Retinal fundus photograph
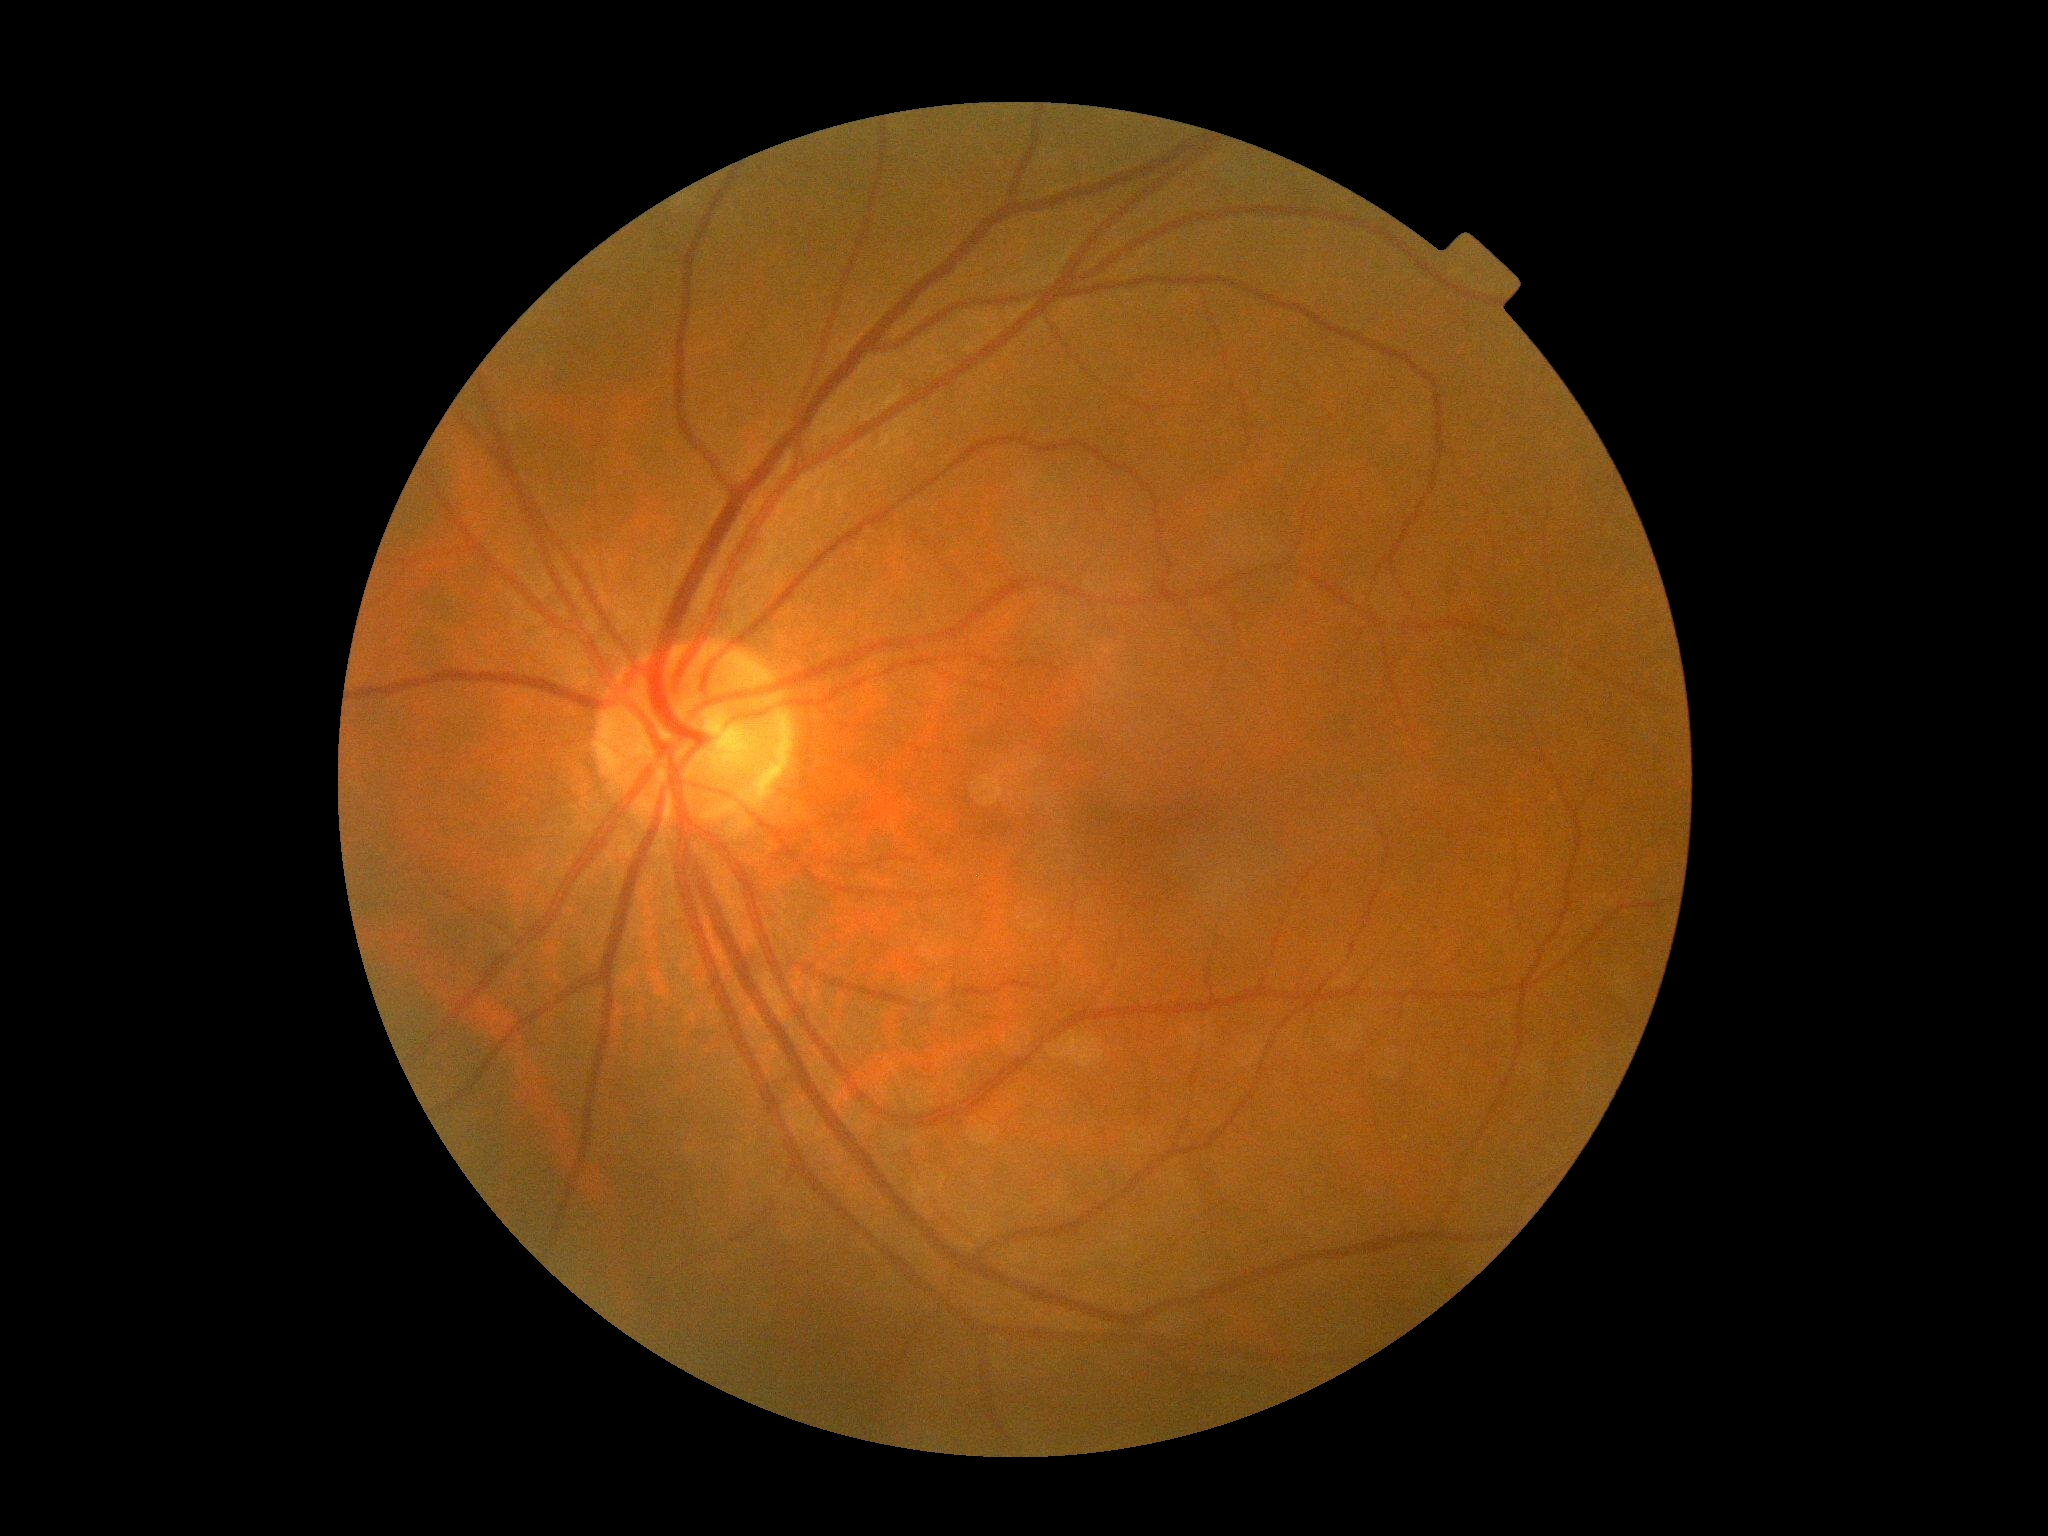 dr_grade: 0